Nonmydriatic · CFP · 848 x 848 pixels · 45-degree field of view · camera: NIDEK AFC-230.
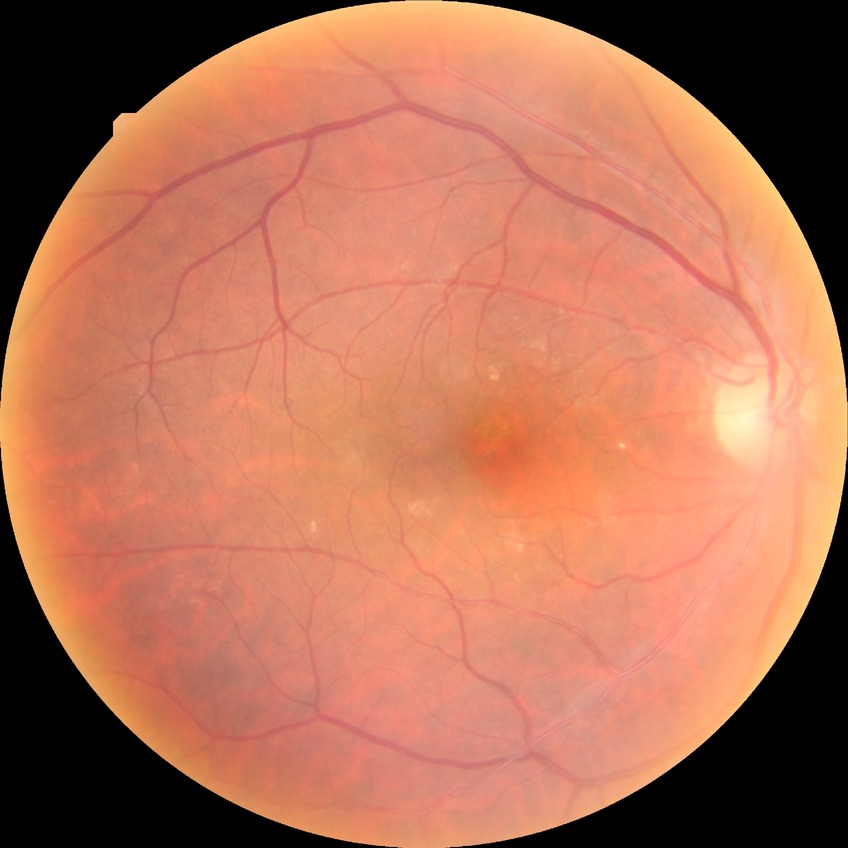
Diabetic retinopathy (DR): no diabetic retinopathy (NDR).